2346 by 1568 pixels
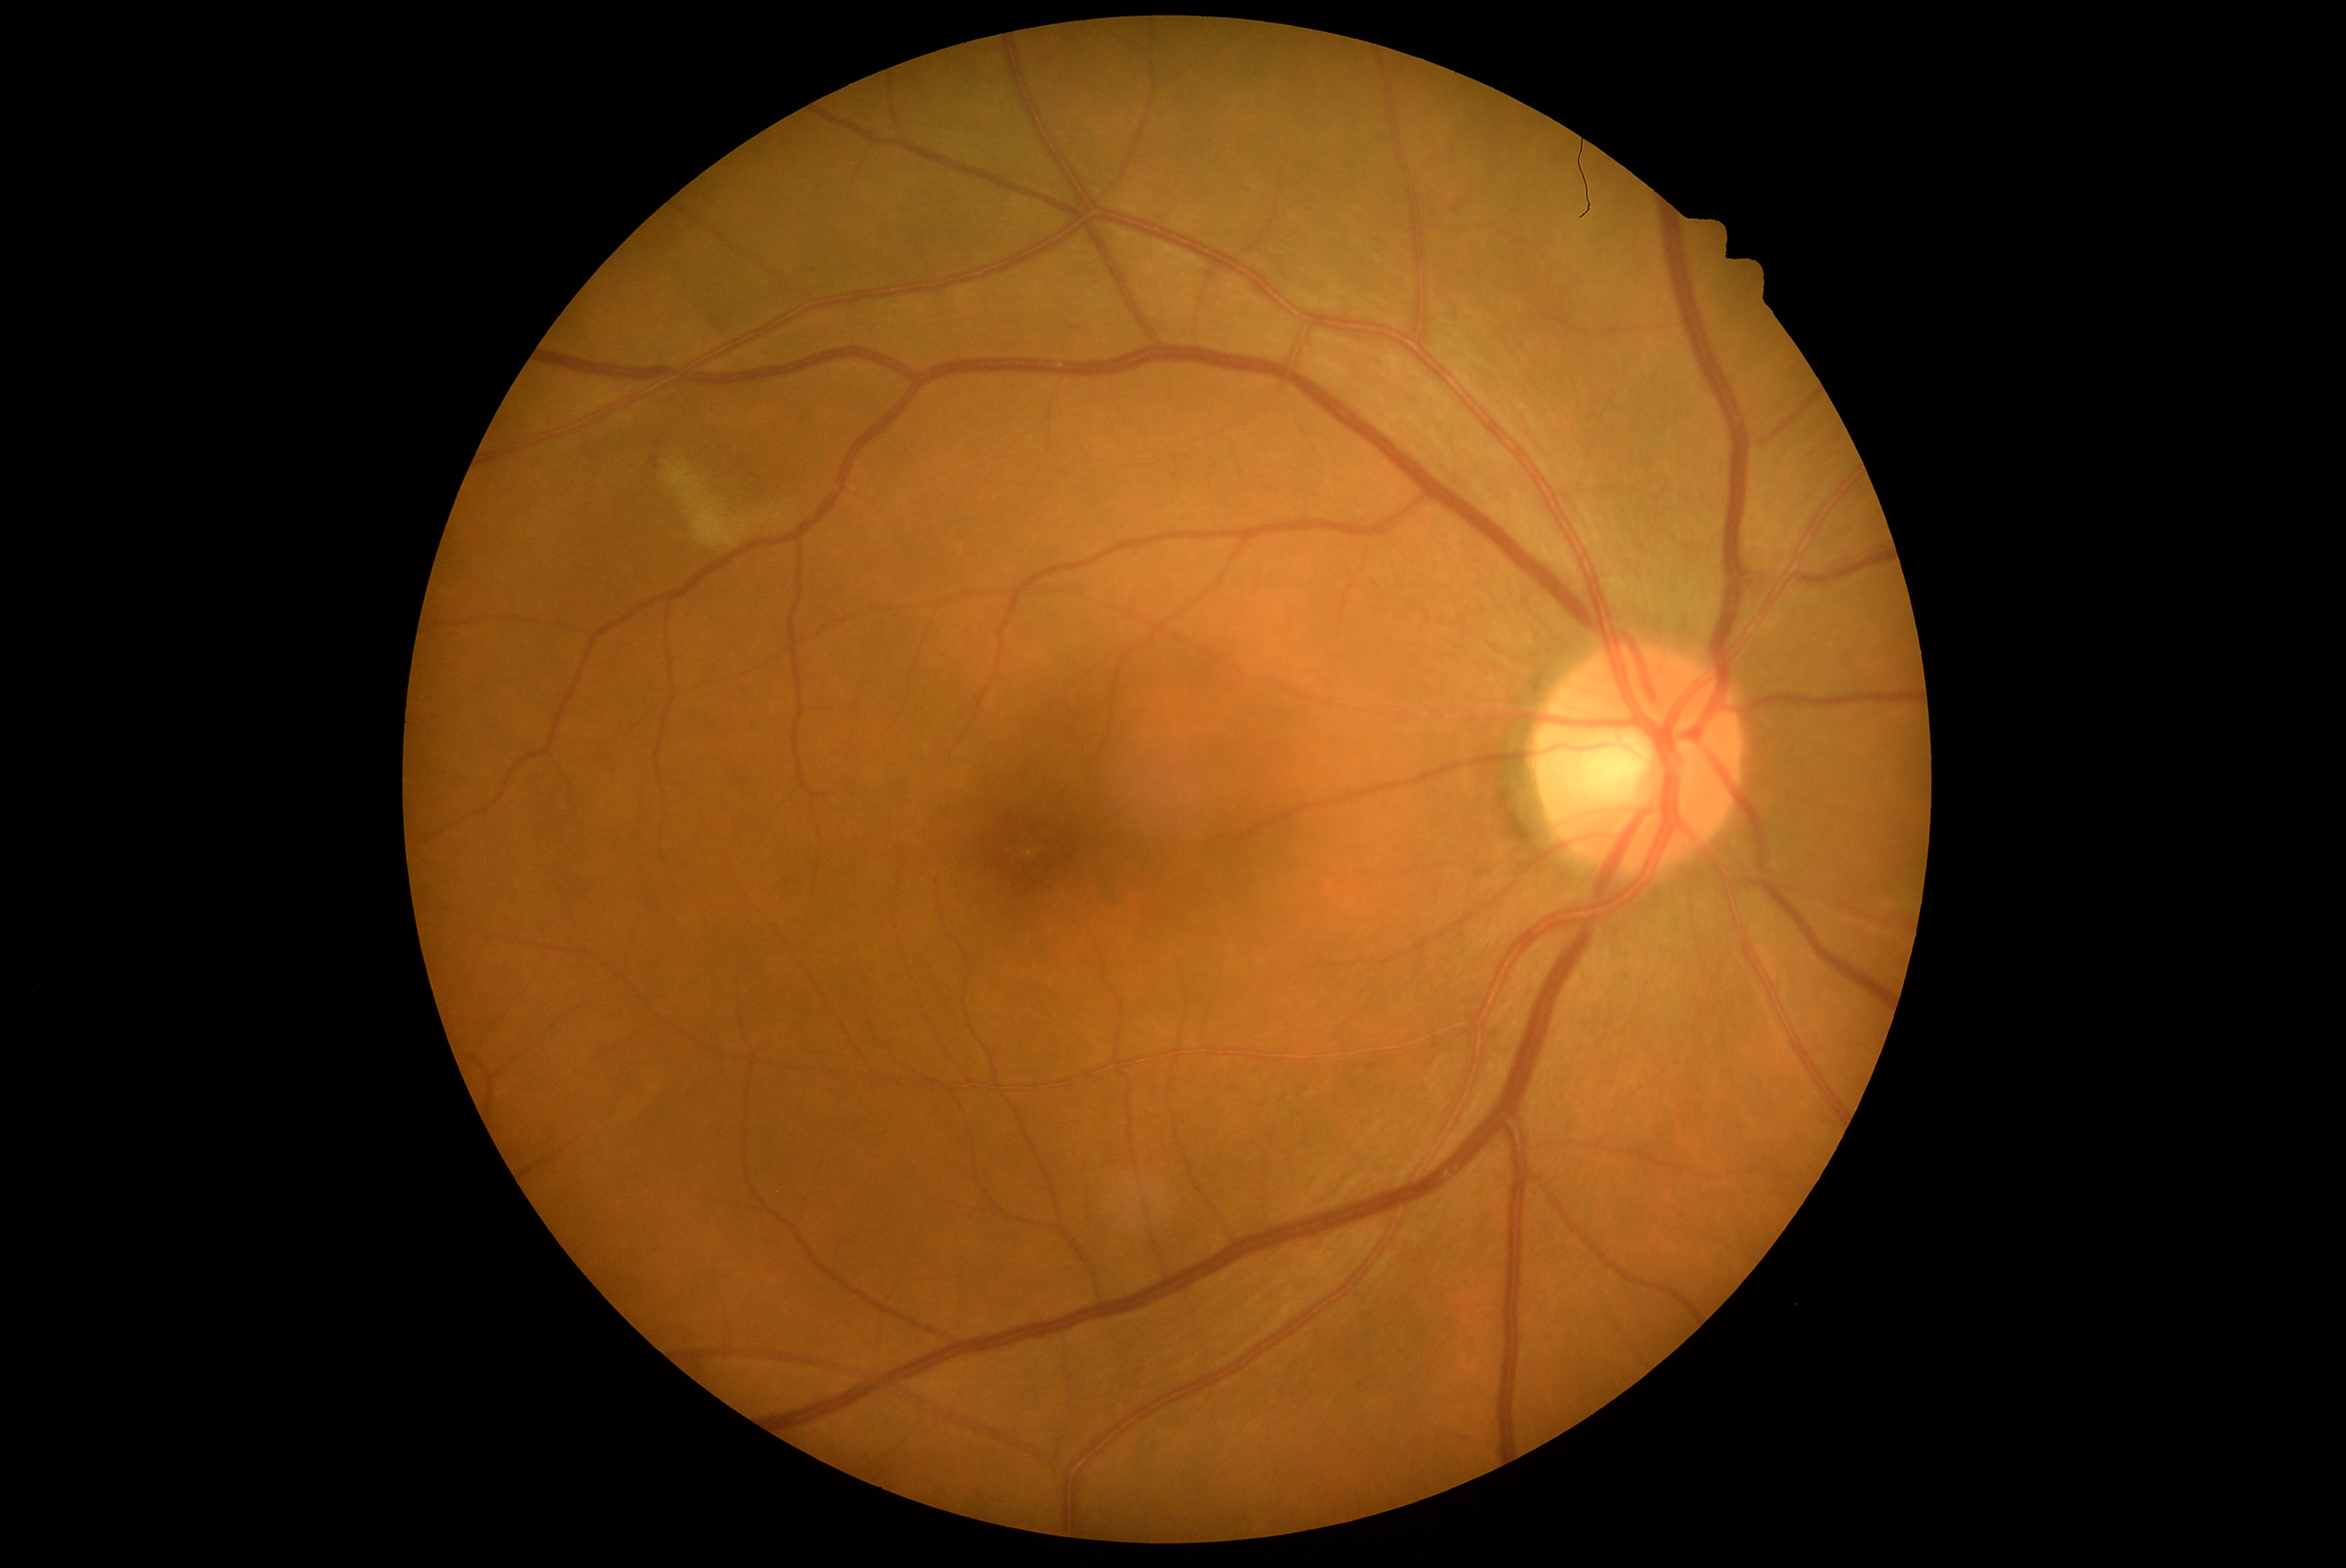 dr_grade: 2